412 x 310 pixels, color fundus image
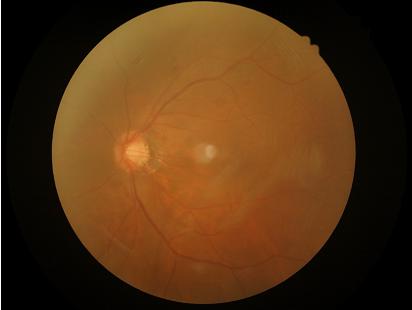
contrast: low
clarity: blurry
illumination: even
overall_quality: poor